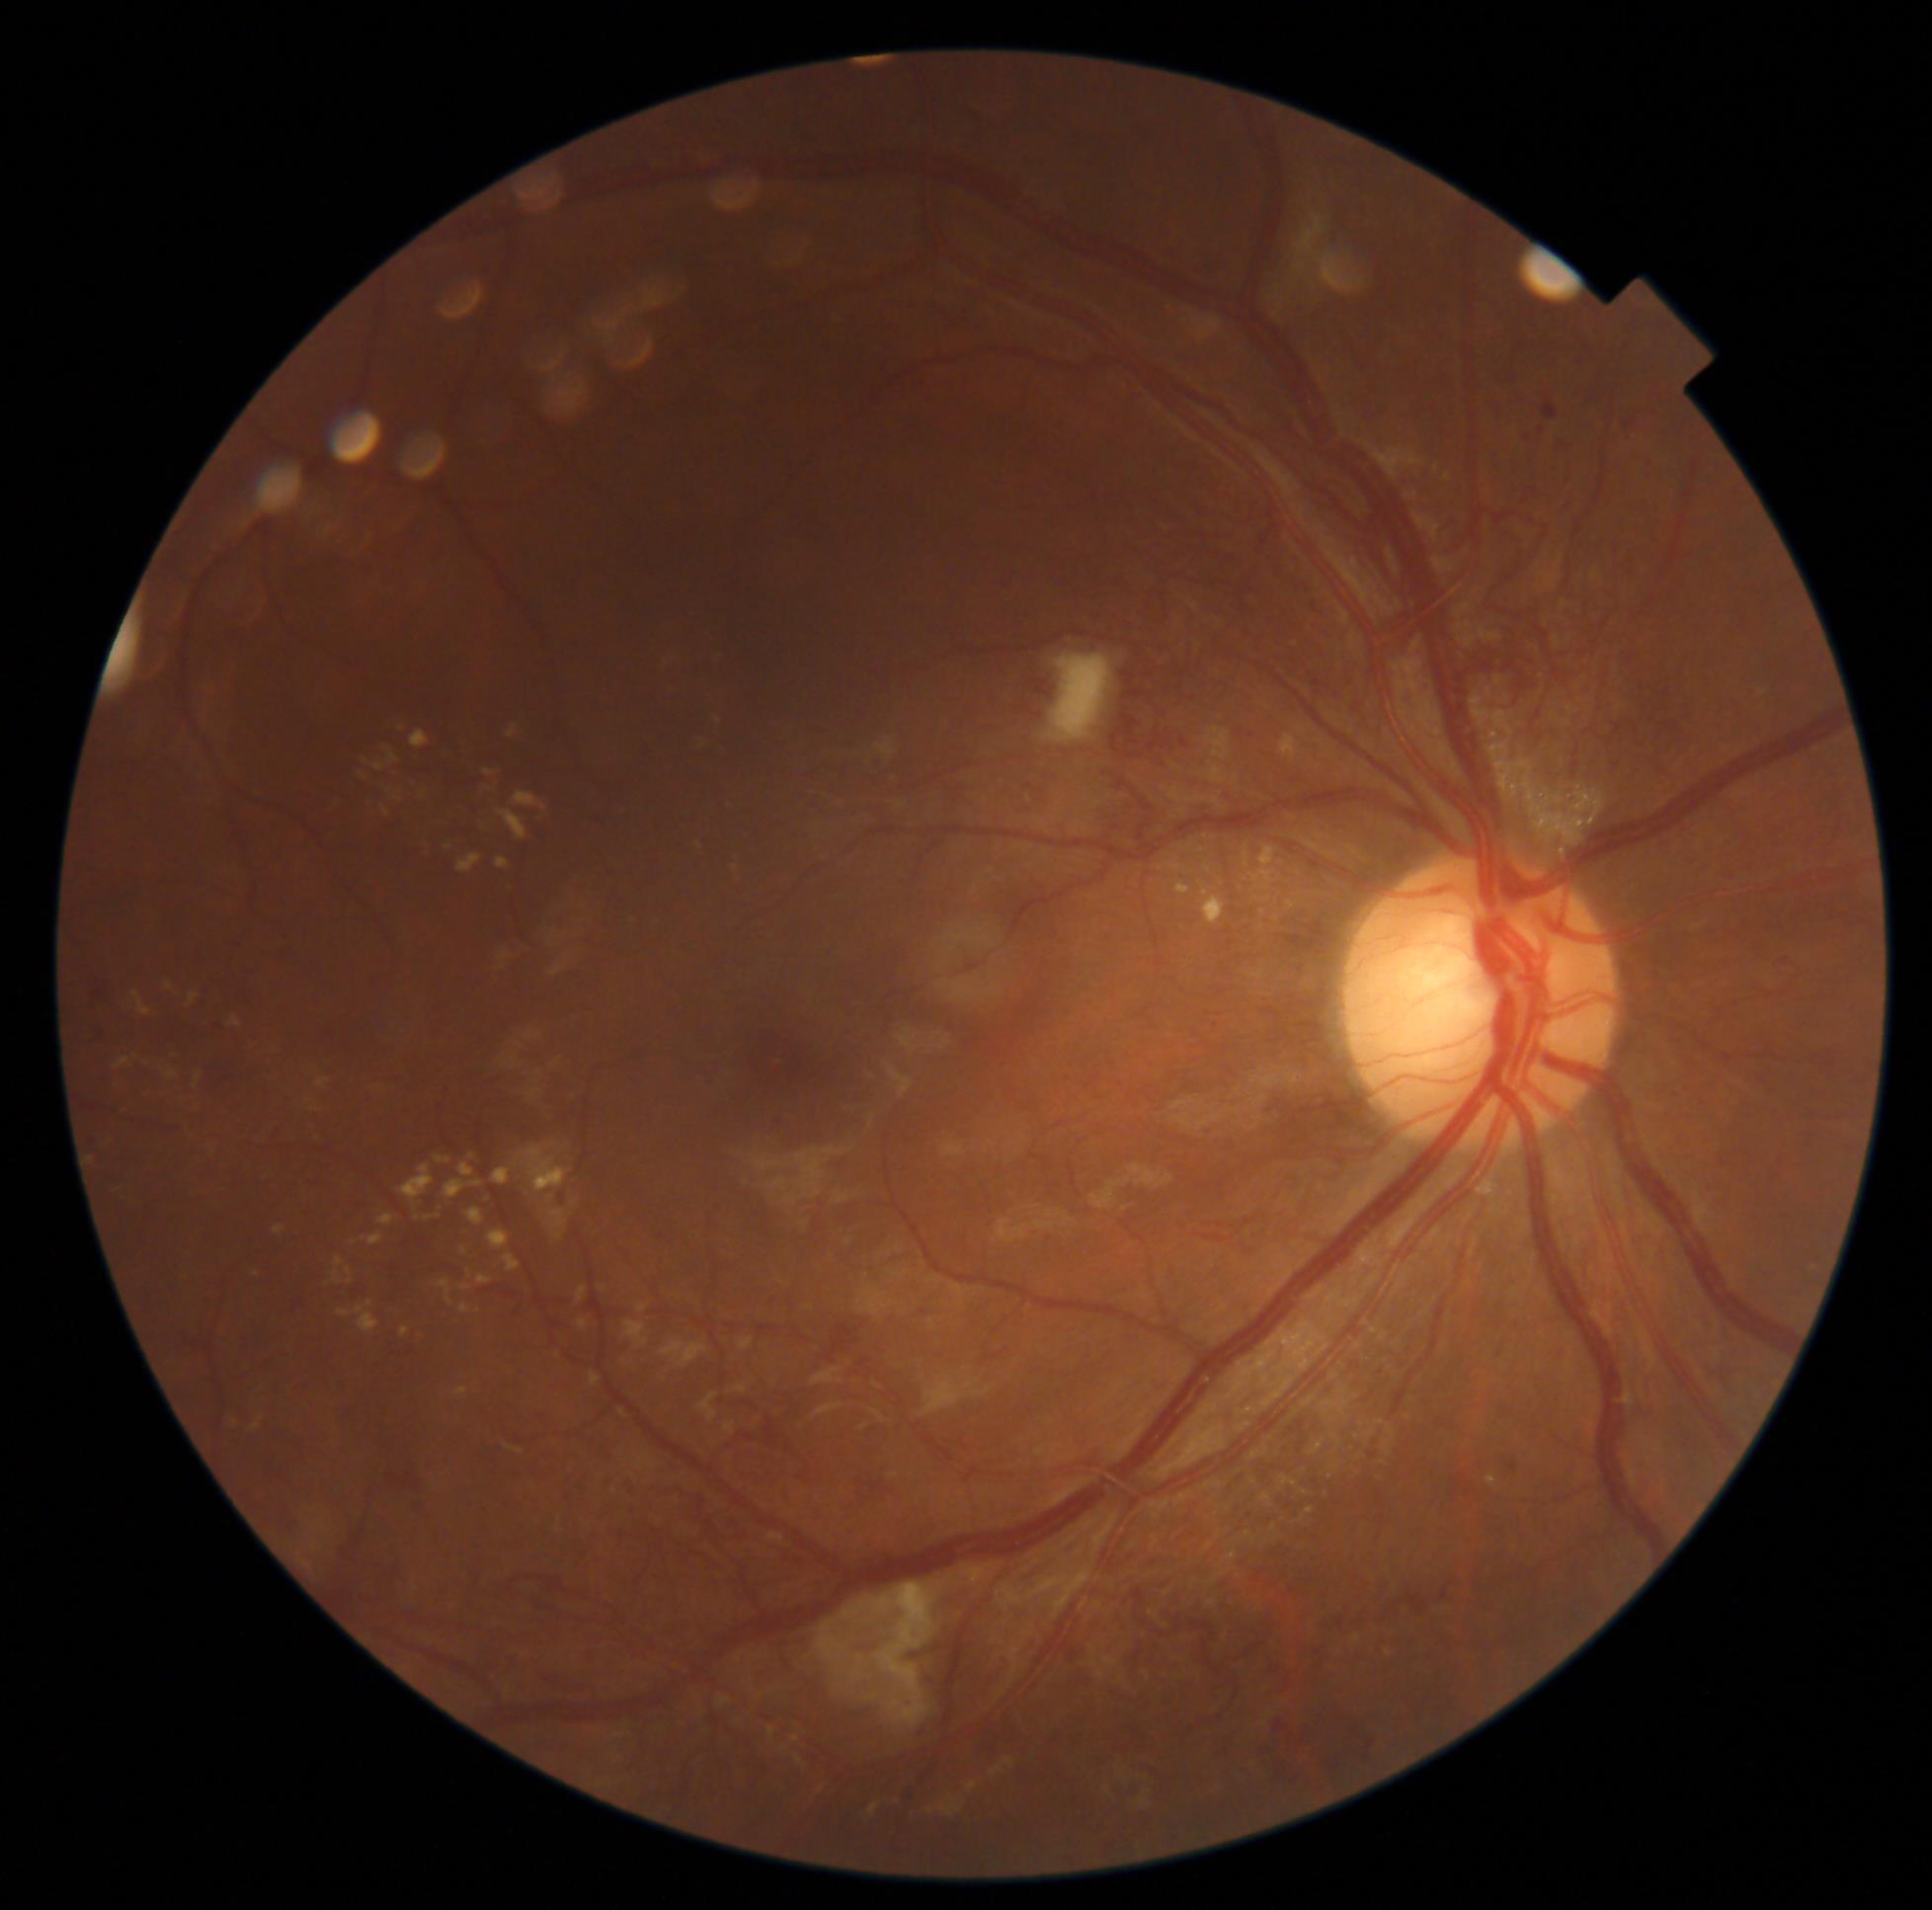
{"dr_category": "proliferative diabetic retinopathy", "dr_grade": "grade 4"}